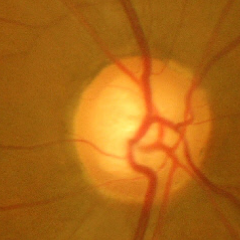
Advanced glaucoma.